2184 by 1690 pixels.
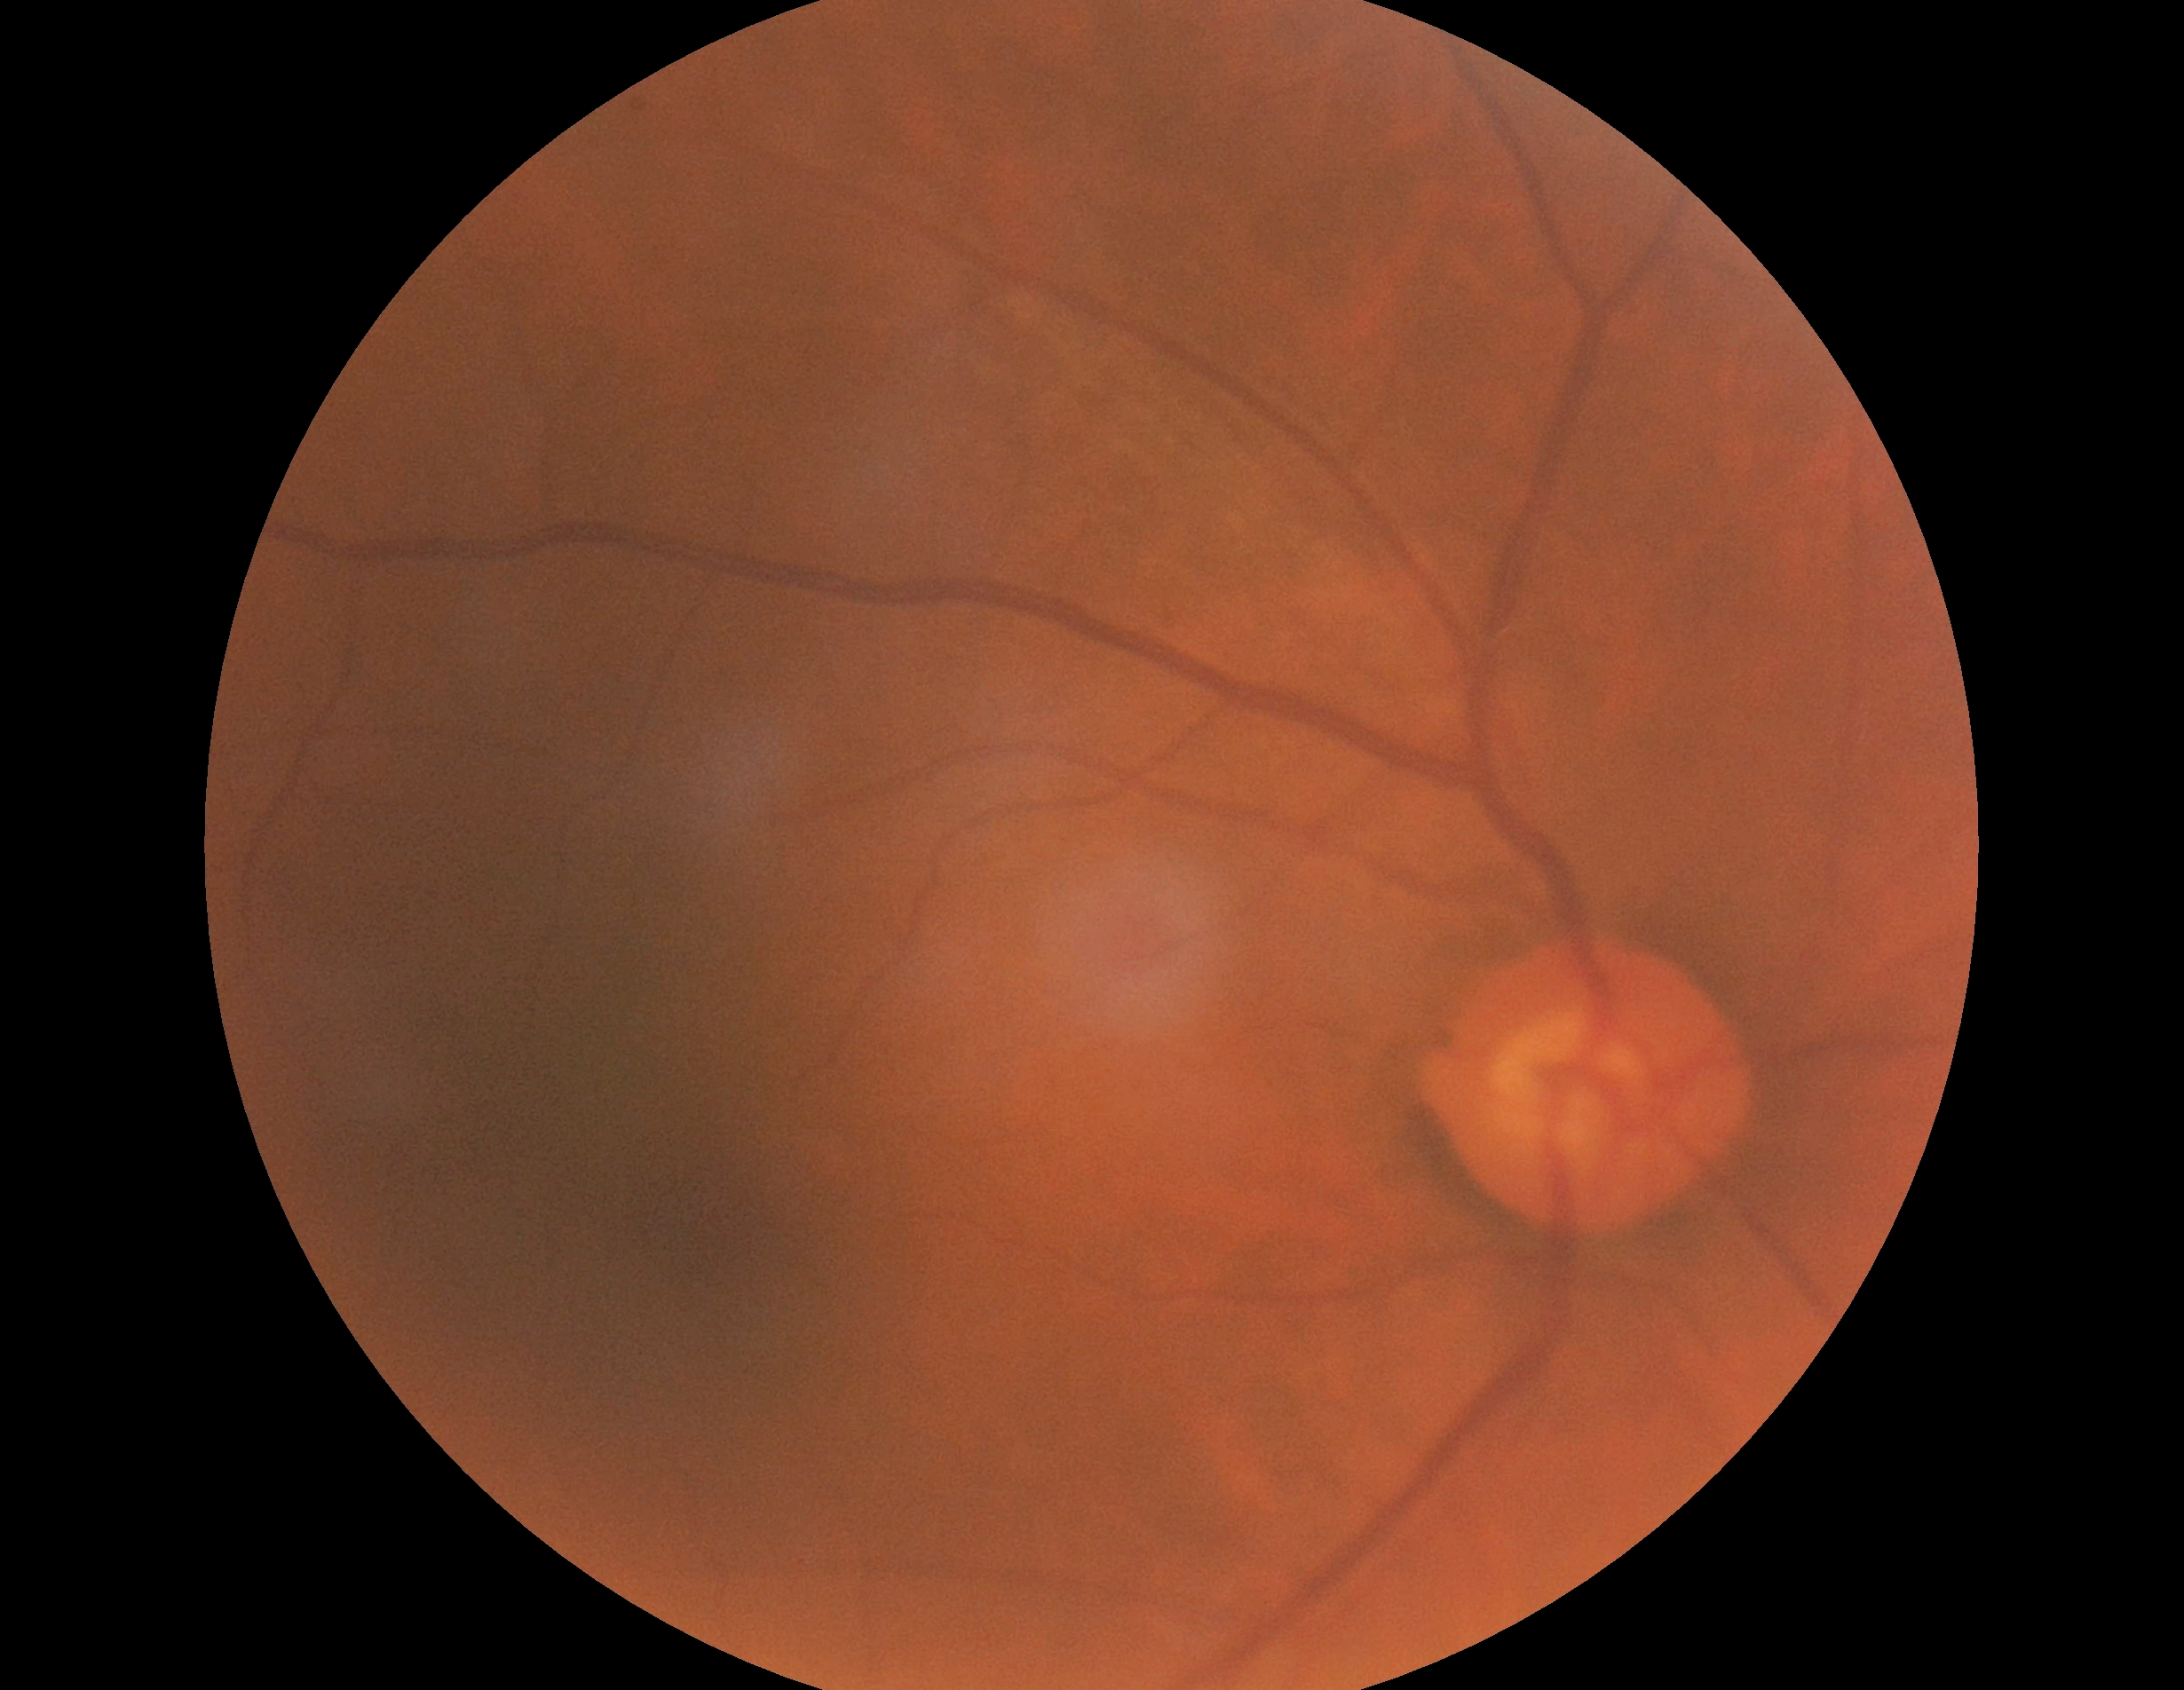
DR grade is 0 (no apparent retinopathy).